Image size 848x848.
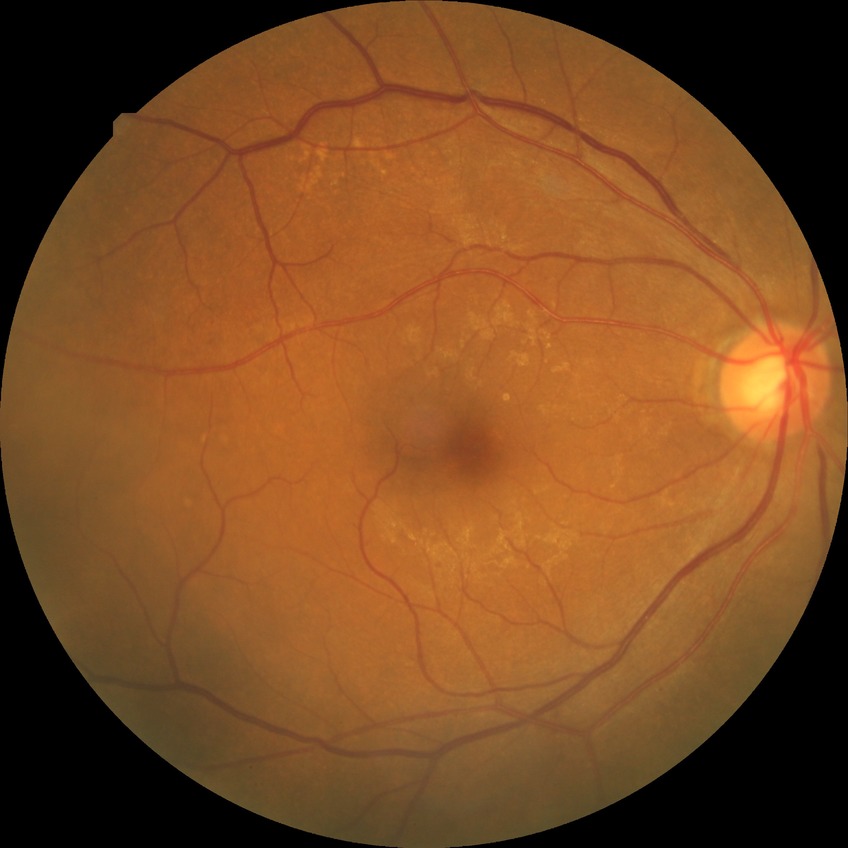 modified Davis classification = pre-proliferative diabetic retinopathy.